Diabetic retinopathy graded by the modified Davis classification; 45-degree field of view; color fundus image
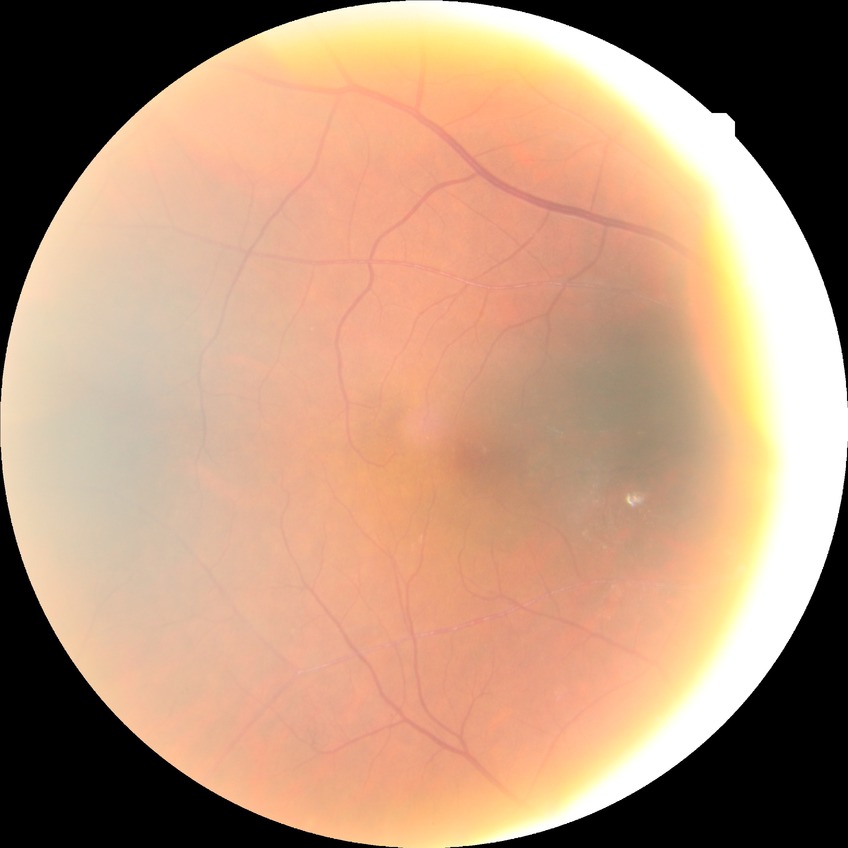 DR grade@SDR.